Wide-field contact fundus photograph of an infant:
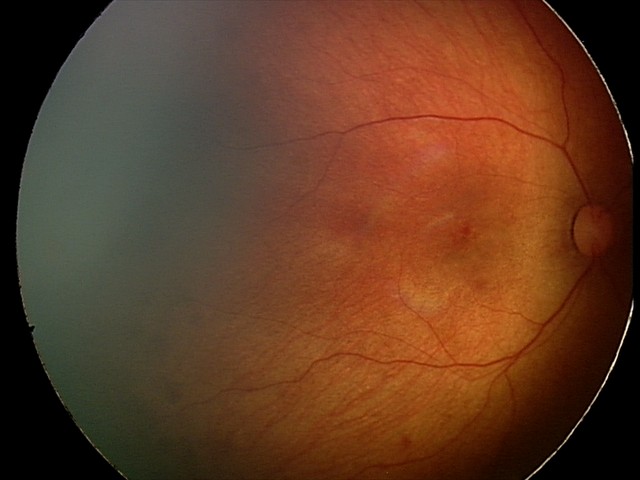
Impression: retinal hemorrhages.